45° field of view, modified Davis classification.
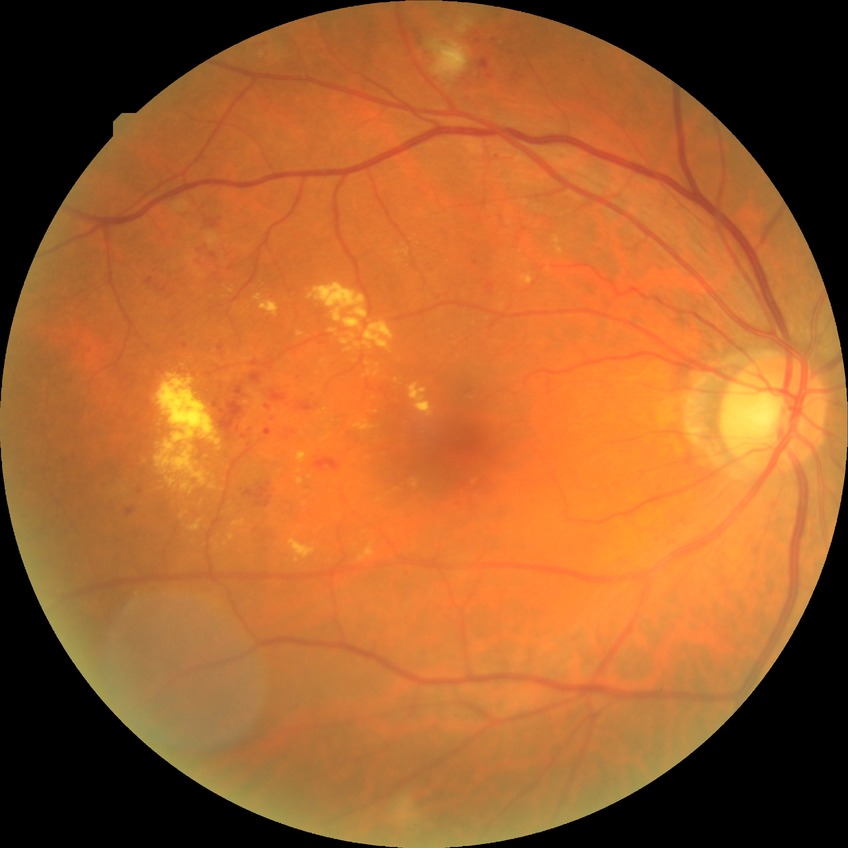 Diabetic retinopathy (DR): pre-proliferative diabetic retinopathy (PPDR).